848 by 848 pixels · color fundus photograph · camera: NIDEK AFC-230.
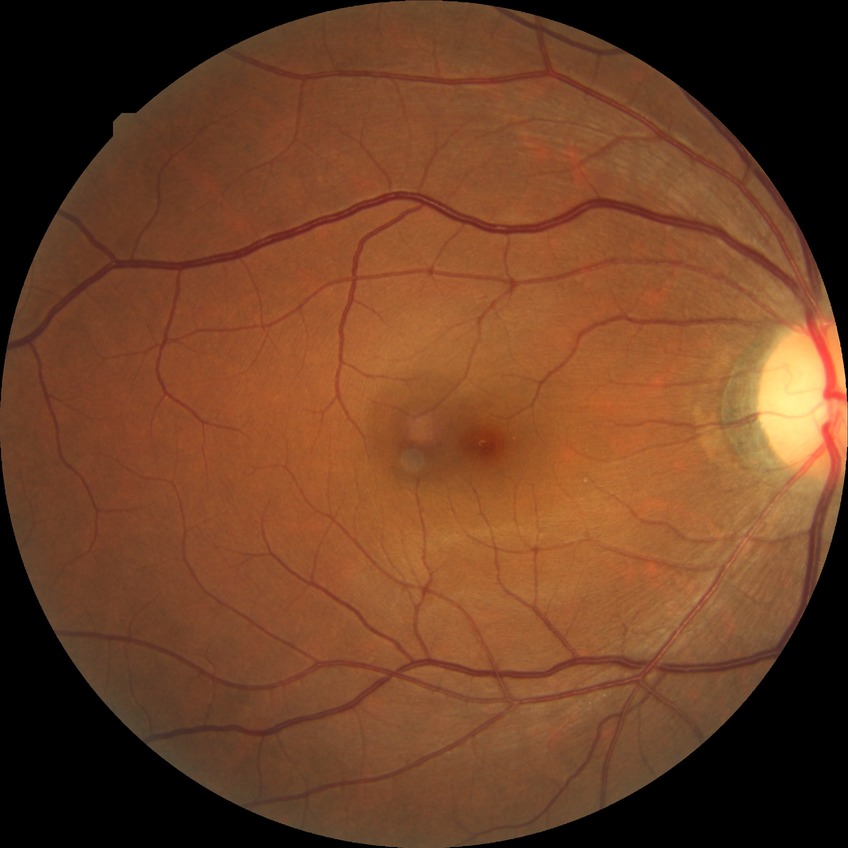

diabetic retinopathy stage: no diabetic retinopathy